2352x1568: 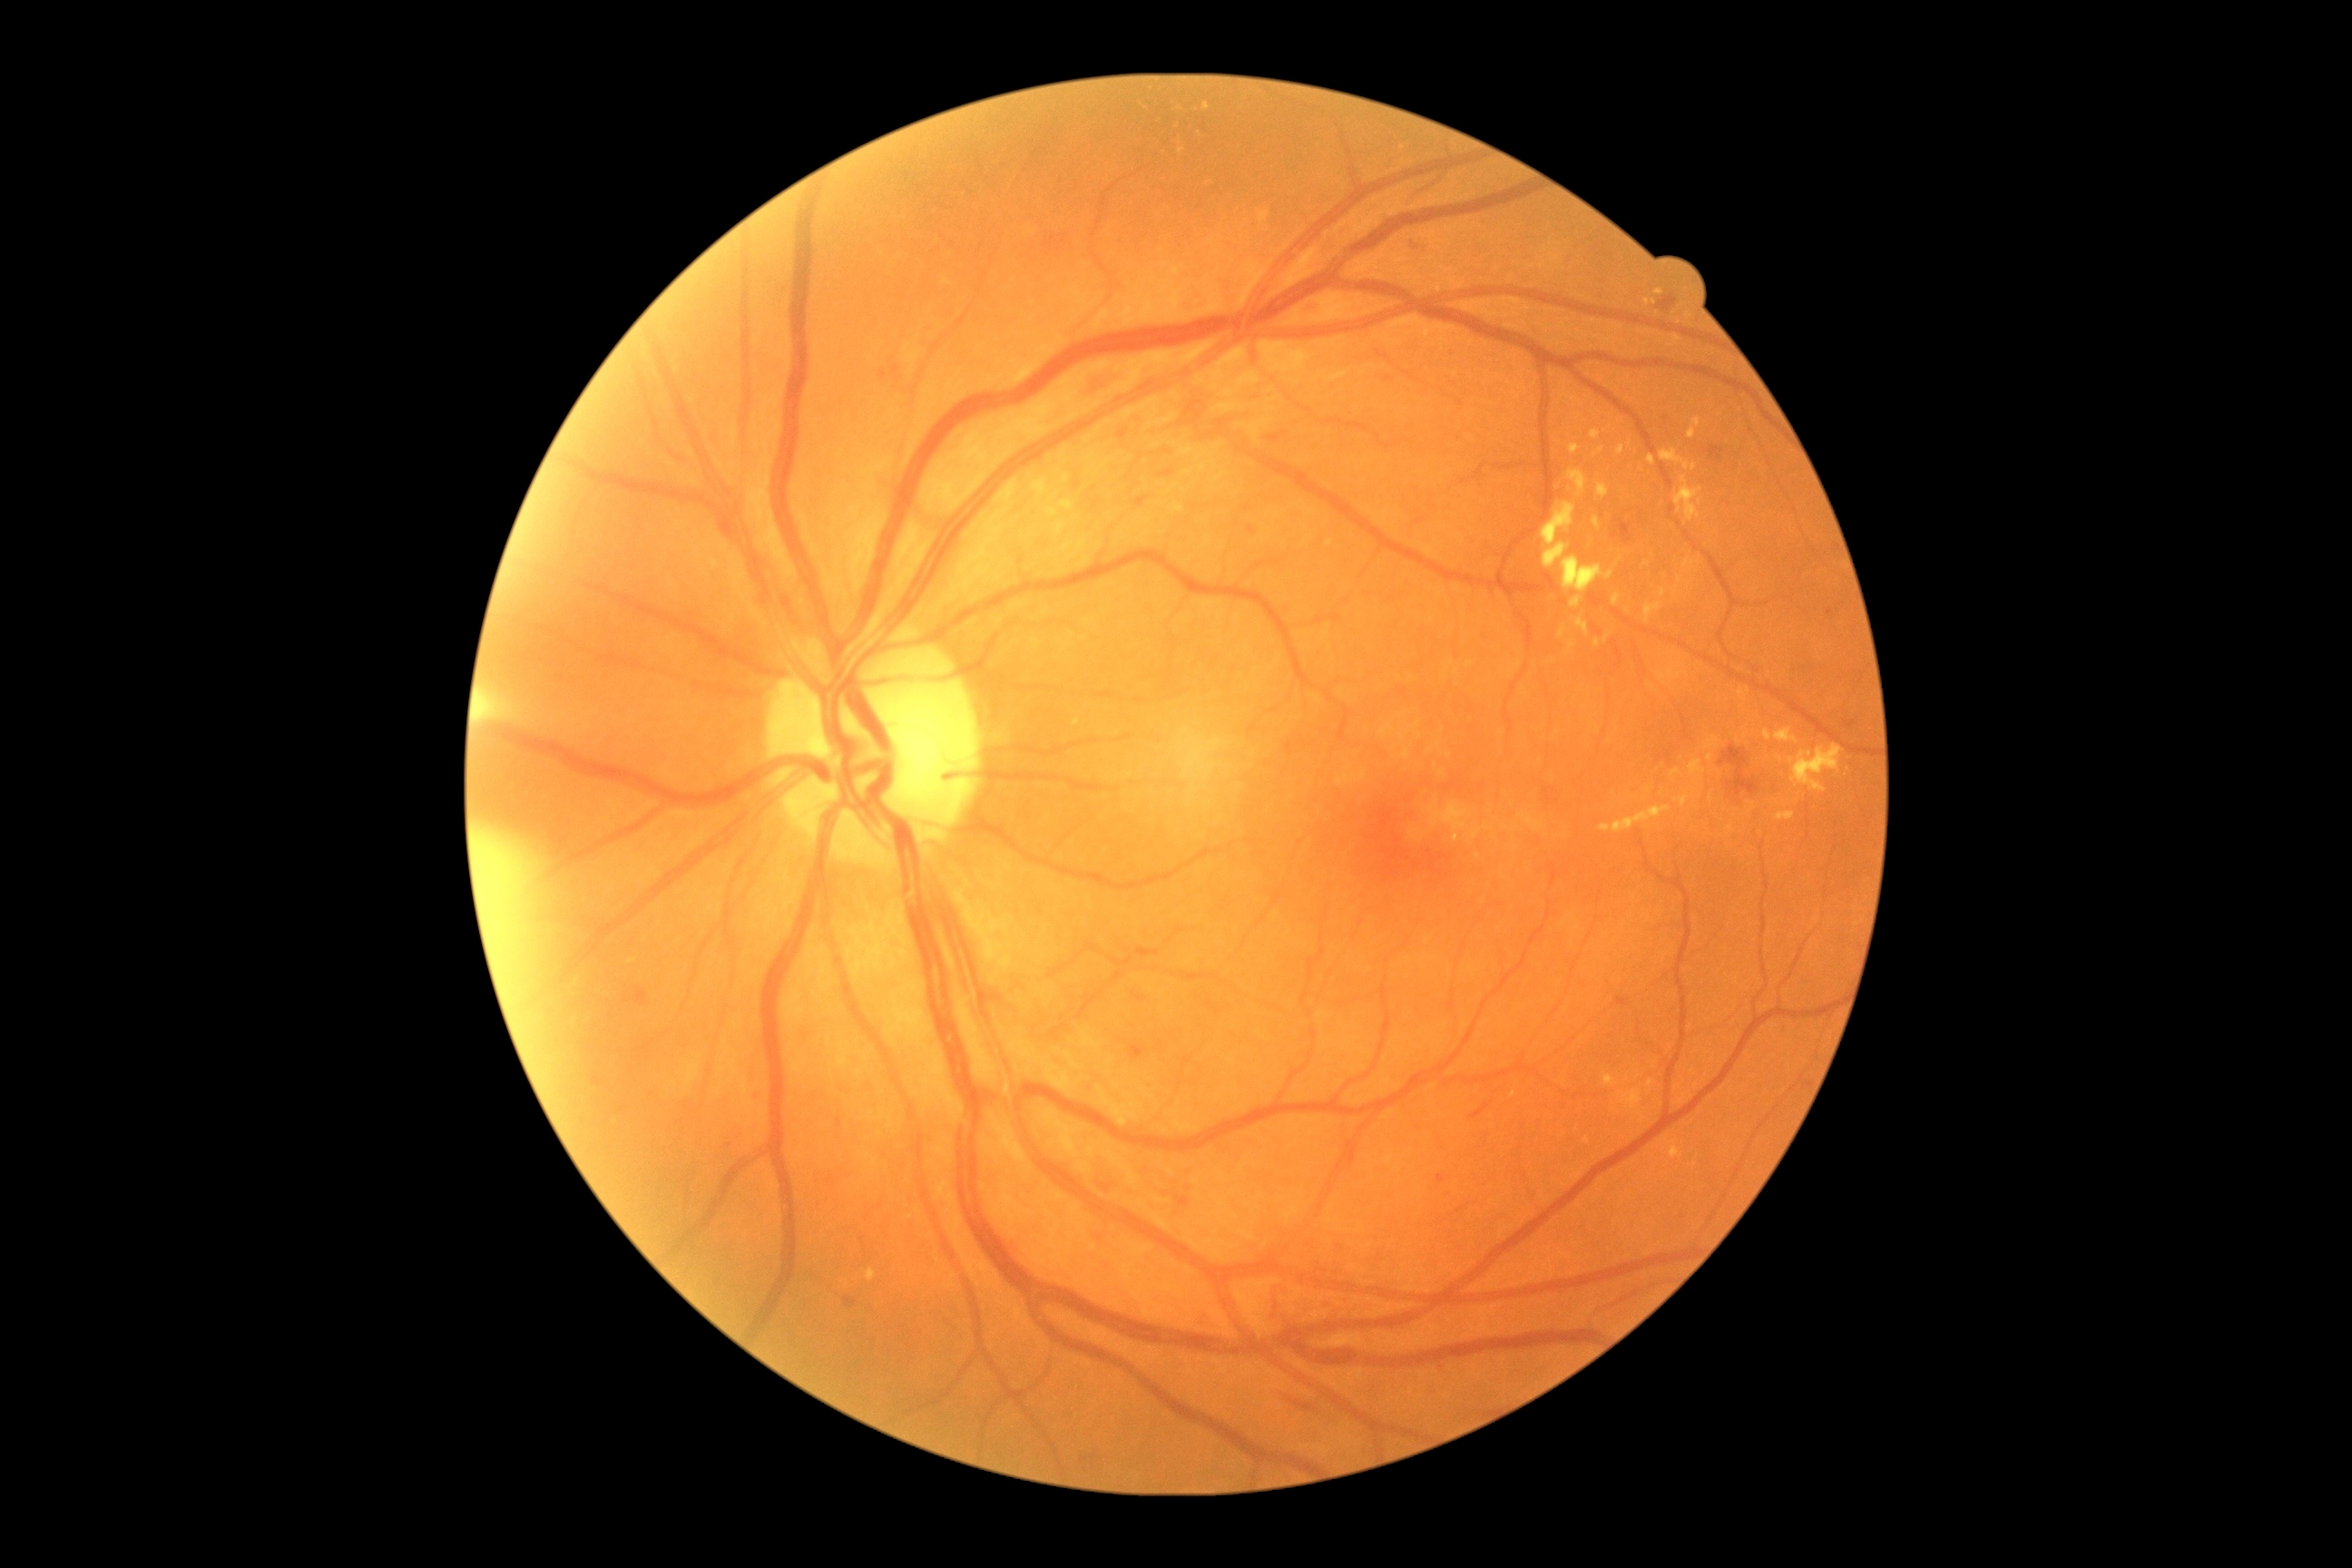
partial: true
dr_grade: 2
dr_grade_name: moderate NPDR
lesions:
  he:
    - [x1=1289, y1=1398, x2=1315, y2=1411]
    - [x1=1268, y1=435, x2=1280, y2=442]
    - [x1=1471, y1=1104, x2=1489, y2=1119]
    - [x1=1720, y1=747, x2=1759, y2=796]
    - [x1=1155, y1=460, x2=1177, y2=480]
    - [x1=1656, y1=295, x2=1678, y2=311]
    - [x1=1709, y1=447, x2=1725, y2=460]
    - [x1=625, y1=988, x2=647, y2=1006]
    - [x1=1133, y1=495, x2=1150, y2=507]
    - [x1=1119, y1=429, x2=1128, y2=440]
    - [x1=876, y1=346, x2=899, y2=386]
    - [x1=1079, y1=362, x2=1124, y2=393]
    - [x1=1409, y1=239, x2=1422, y2=255]
    - [x1=1620, y1=522, x2=1632, y2=544]
  ma:
    - [x1=1175, y1=1195, x2=1190, y2=1208]
    - [x1=1308, y1=304, x2=1317, y2=313]
    - [x1=1438, y1=1175, x2=1446, y2=1184]
    - [x1=1847, y1=721, x2=1857, y2=729]
    - [x1=754, y1=1092, x2=761, y2=1101]
    - [x1=1248, y1=525, x2=1255, y2=534]
    - [x1=1126, y1=1046, x2=1141, y2=1059]
  ma_small:
    - [1831,613]
    - [1683,1217]
    - [729,1146]
  ex:
    - [x1=1594, y1=447, x2=1605, y2=456]
    - [x1=1643, y1=299, x2=1656, y2=306]
    - [x1=867, y1=1269, x2=876, y2=1282]
    - [x1=1776, y1=729, x2=1799, y2=745]
    - [x1=1596, y1=484, x2=1609, y2=498]
    - [x1=1661, y1=449, x2=1698, y2=471]
    - [x1=1656, y1=289, x2=1665, y2=297]
    - [x1=1689, y1=418, x2=1701, y2=440]
    - [x1=1672, y1=769, x2=1680, y2=776]
    - [x1=1204, y1=103, x2=1211, y2=112]
    - [x1=1055, y1=524, x2=1066, y2=536]
    - [x1=1545, y1=502, x2=1614, y2=594]
  ex_small:
    - [1208,180]
    - [1663,793]
    - [1729,827]
    - [1688,587]
  se: []